Graded on the modified Davis scale; camera: NIDEK AFC-230; no pharmacologic dilation
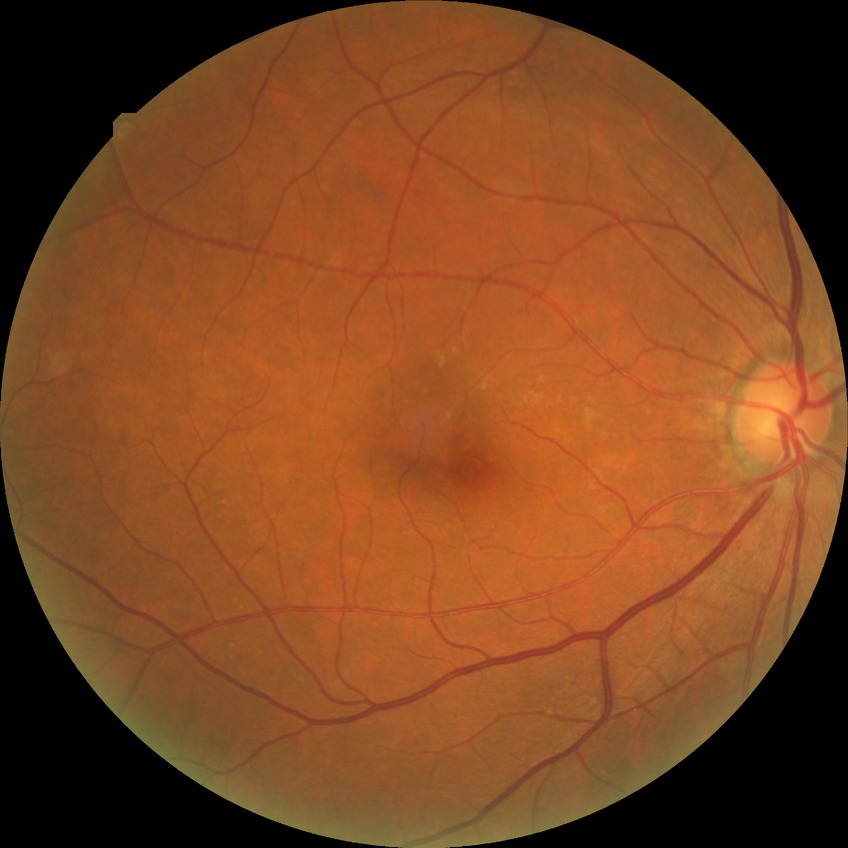

DR grade: NDR
DR impression: no signs of DR